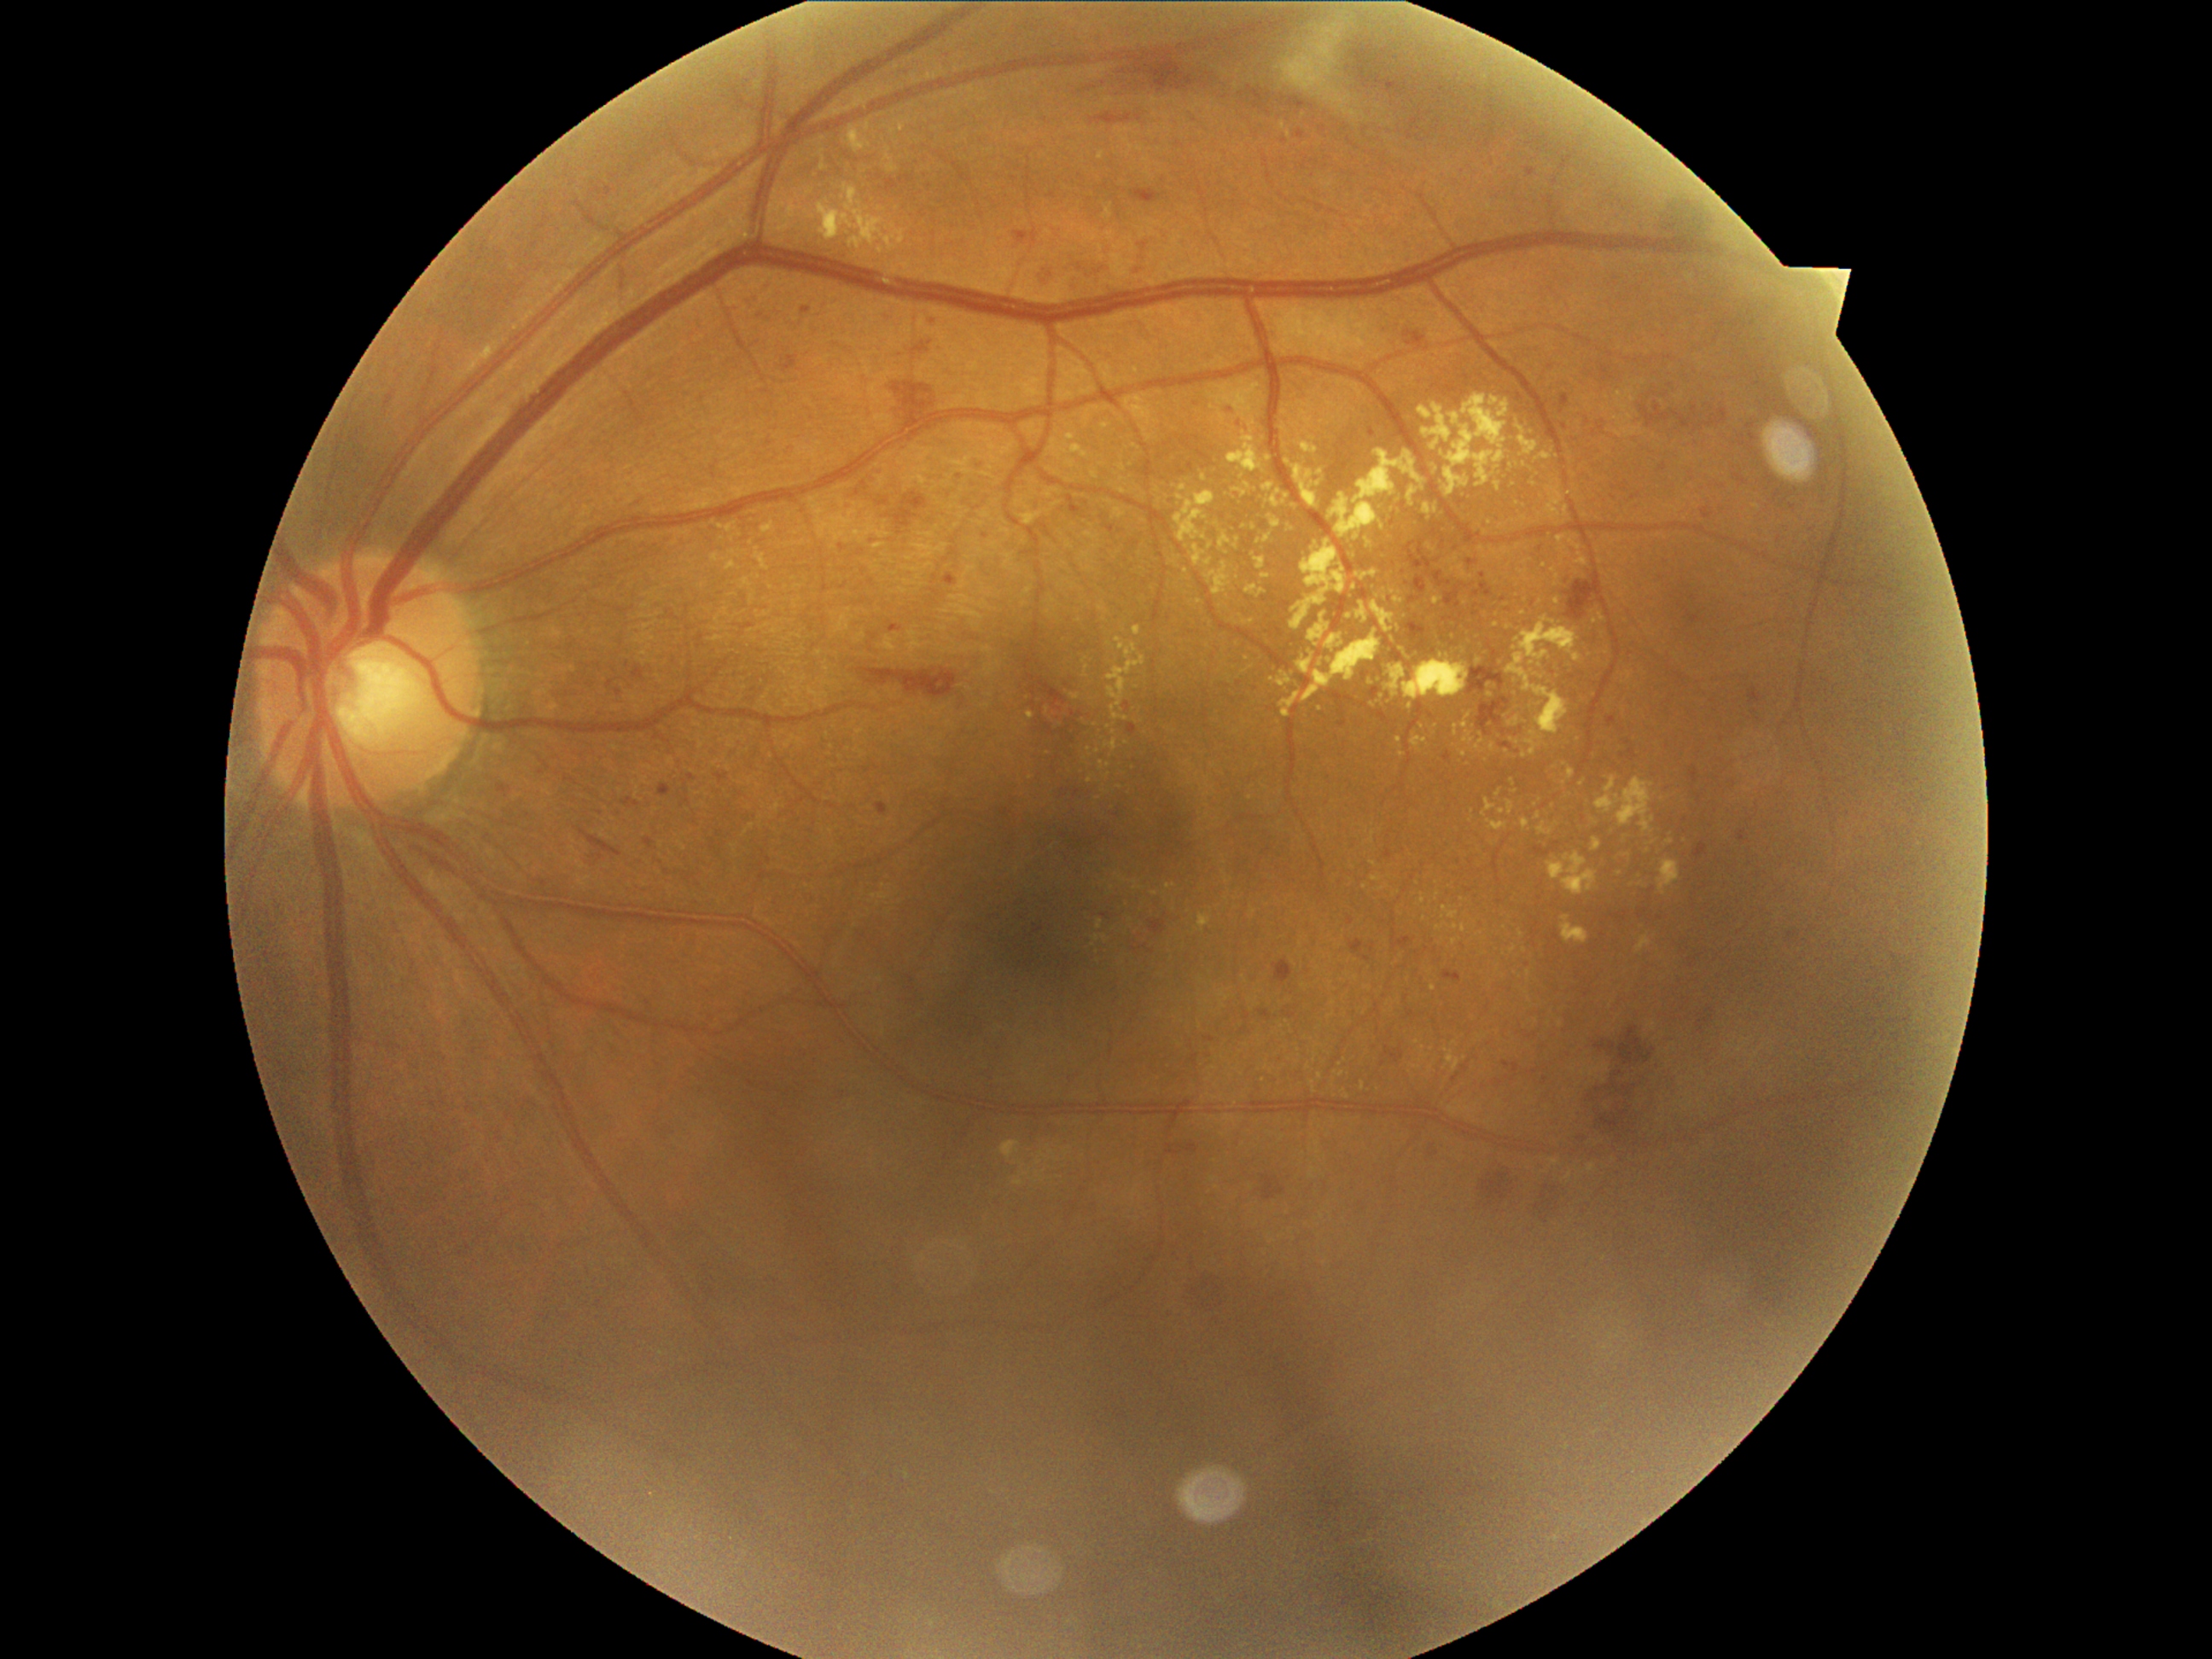
DR severity is grade 2 (moderate NPDR)
Selected lesions:
EXs (partial) = x1=1100 y1=424 x2=1112 y2=431, x1=1428 y1=545 x2=1438 y2=552, x1=1281 y1=692 x2=1301 y2=718, x1=1392 y1=637 x2=1395 y2=646, x1=1286 y1=460 x2=1324 y2=509, x1=1022 y1=513 x2=1044 y2=525, x1=1407 y1=487 x2=1417 y2=508, x1=1535 y1=453 x2=1552 y2=462, x1=1511 y1=738 x2=1520 y2=745, x1=1522 y1=818 x2=1530 y2=830
Smaller EXs around pt(1534, 484), pt(1538, 816), pt(1137, 688), pt(1365, 885), pt(1464, 900), pt(1155, 893), pt(1653, 844), pt(1368, 543), pt(1537, 1021)